45° field of view.
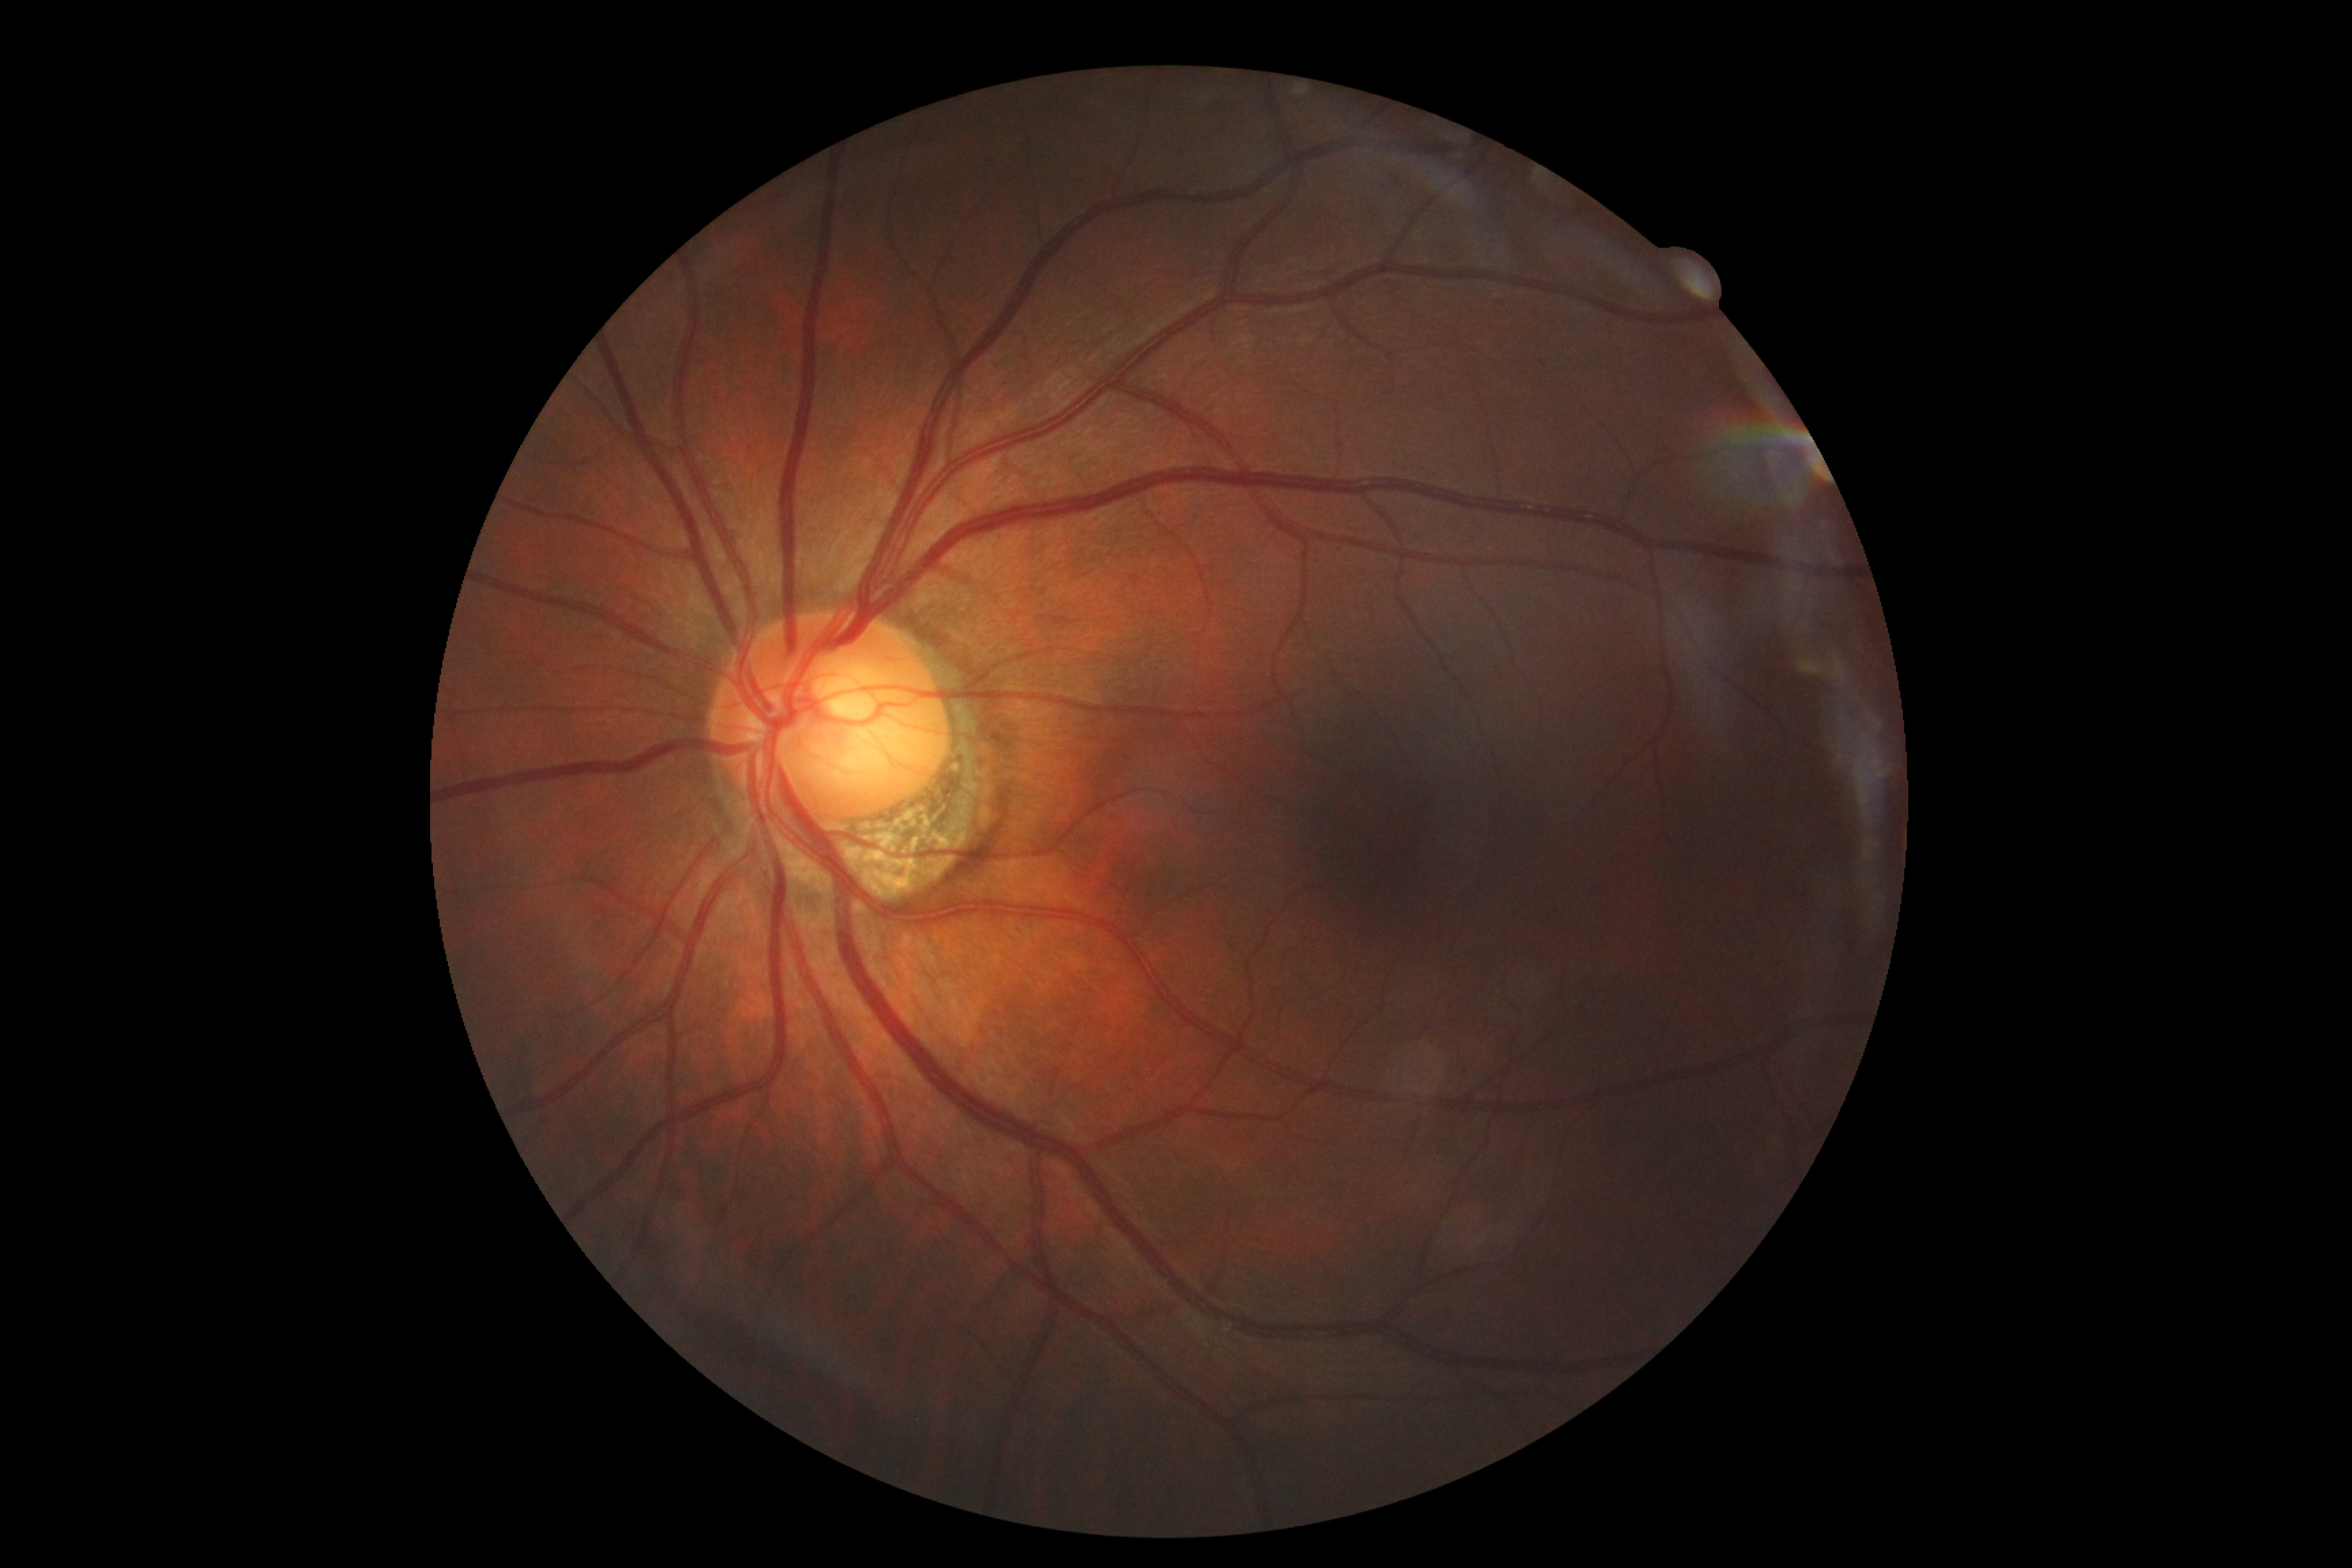

DR grade: 0/4.